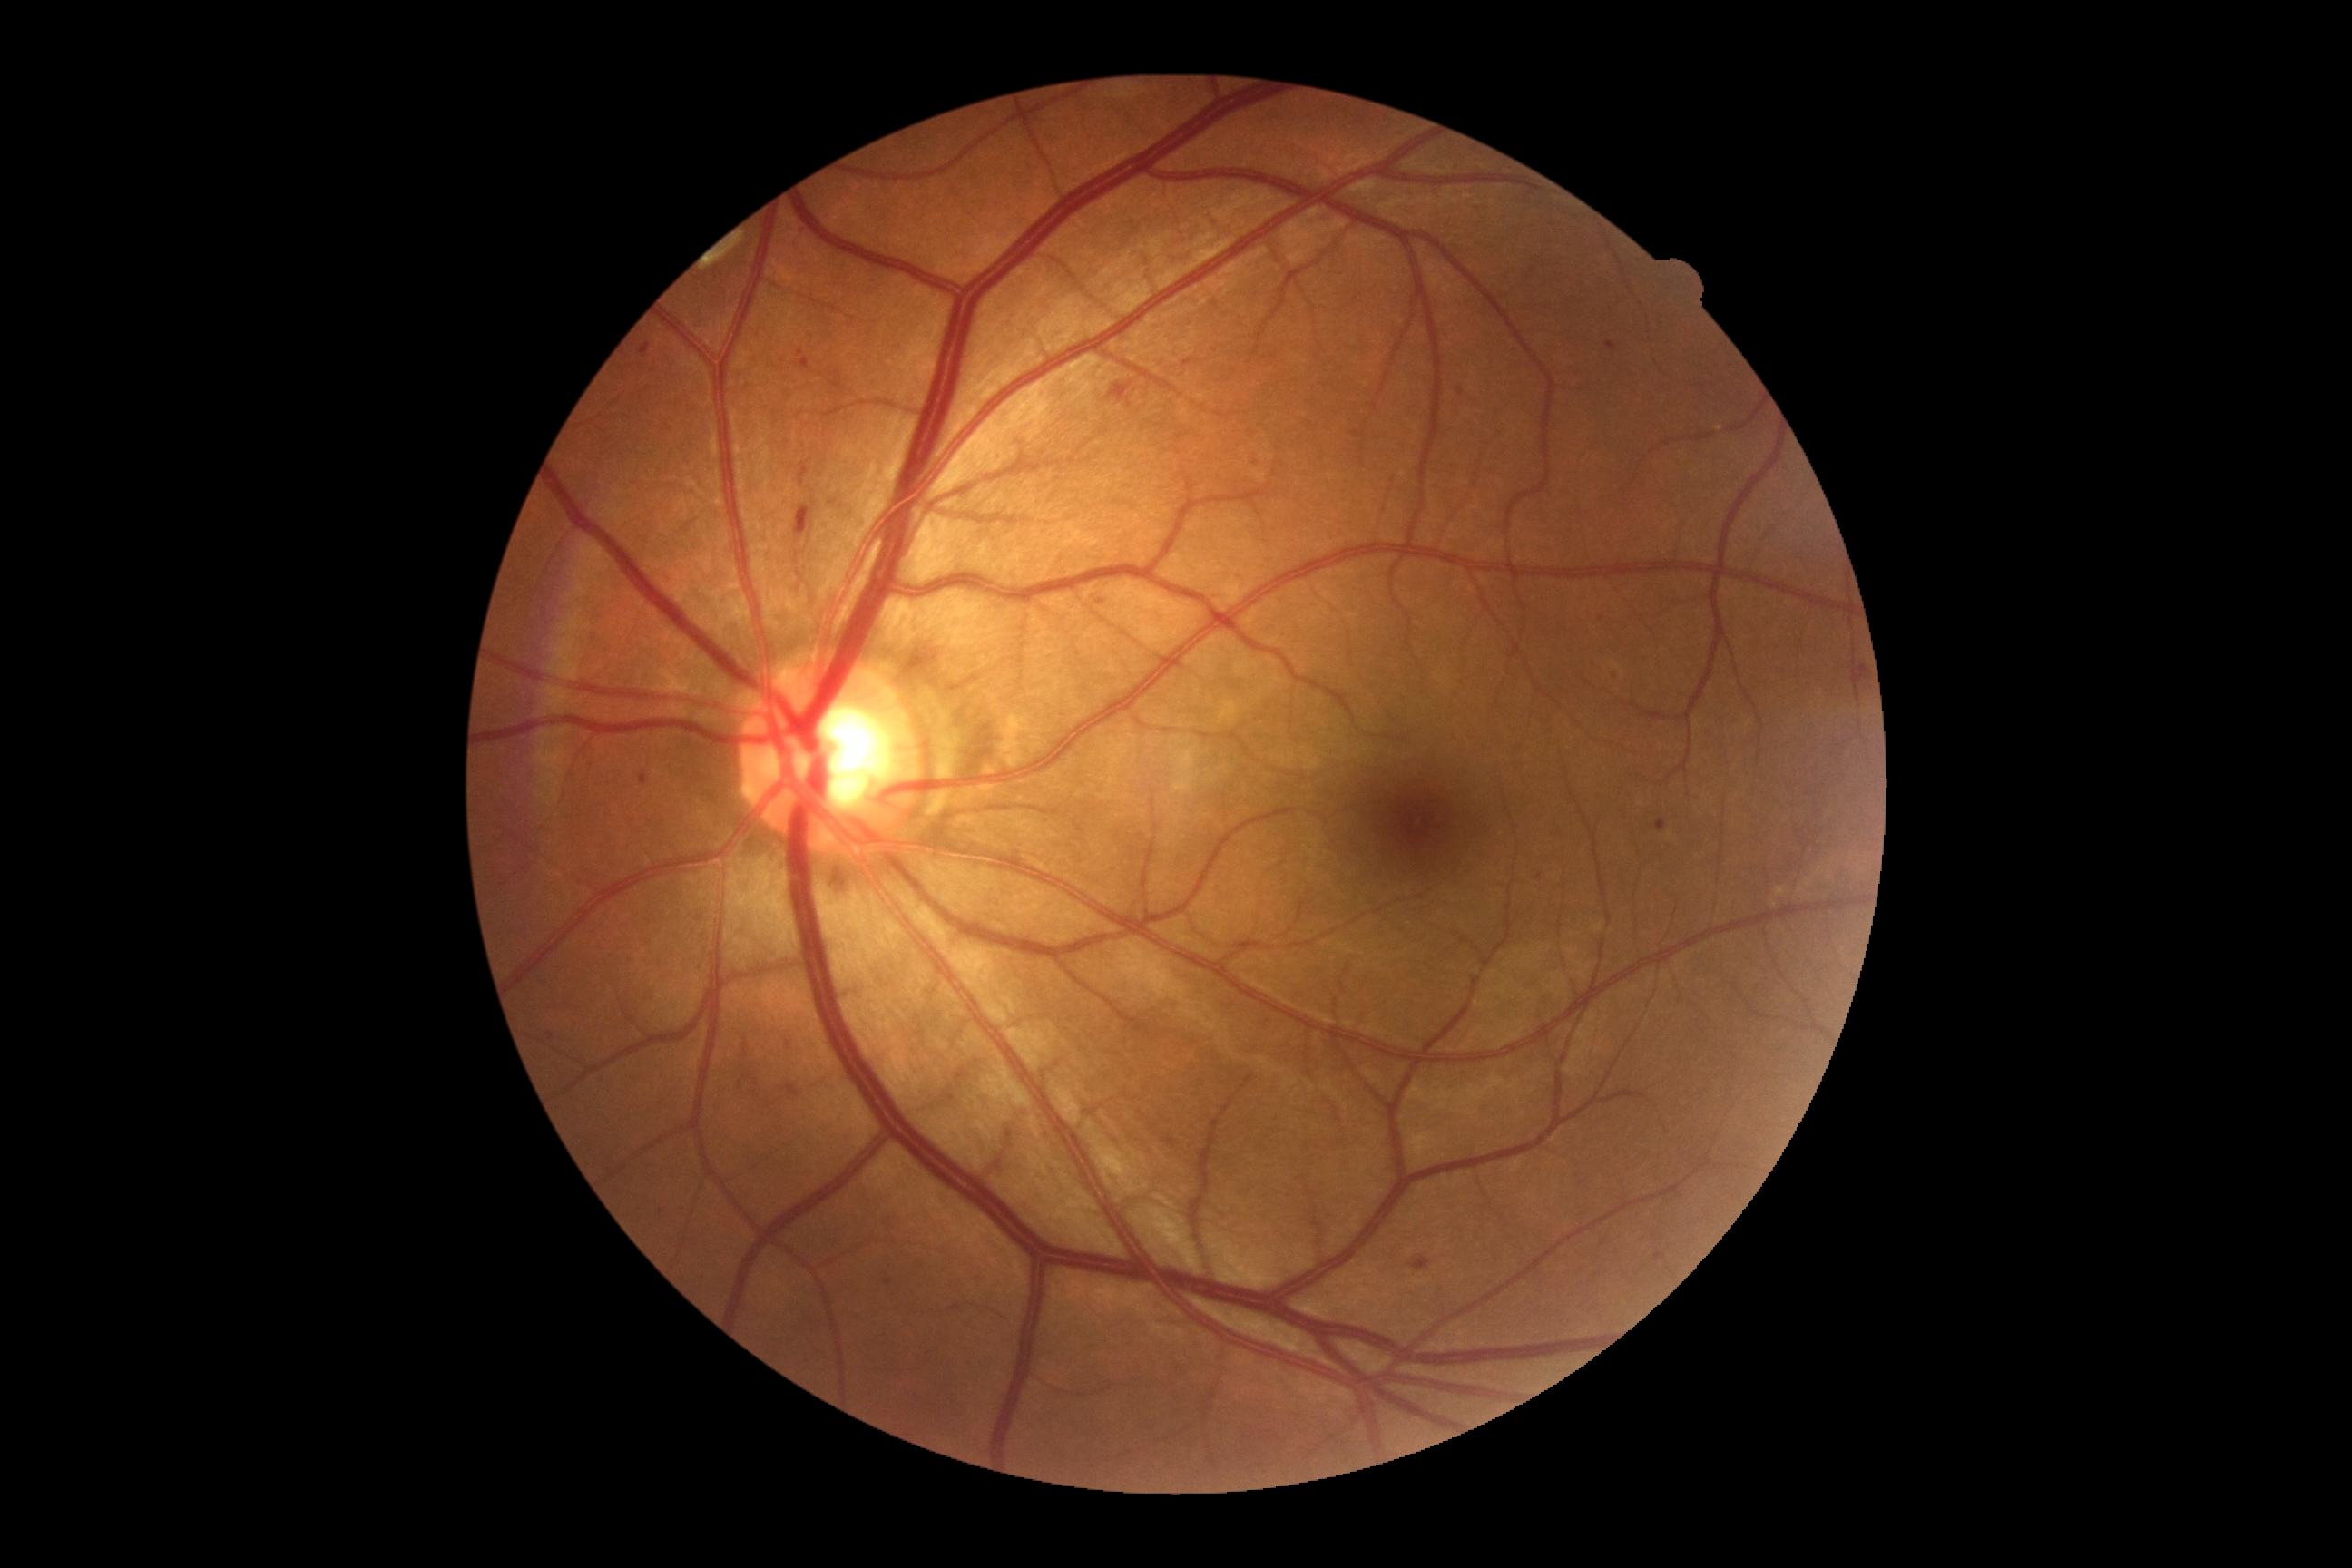

DR: 2/4; DR class: non-proliferative diabetic retinopathy.